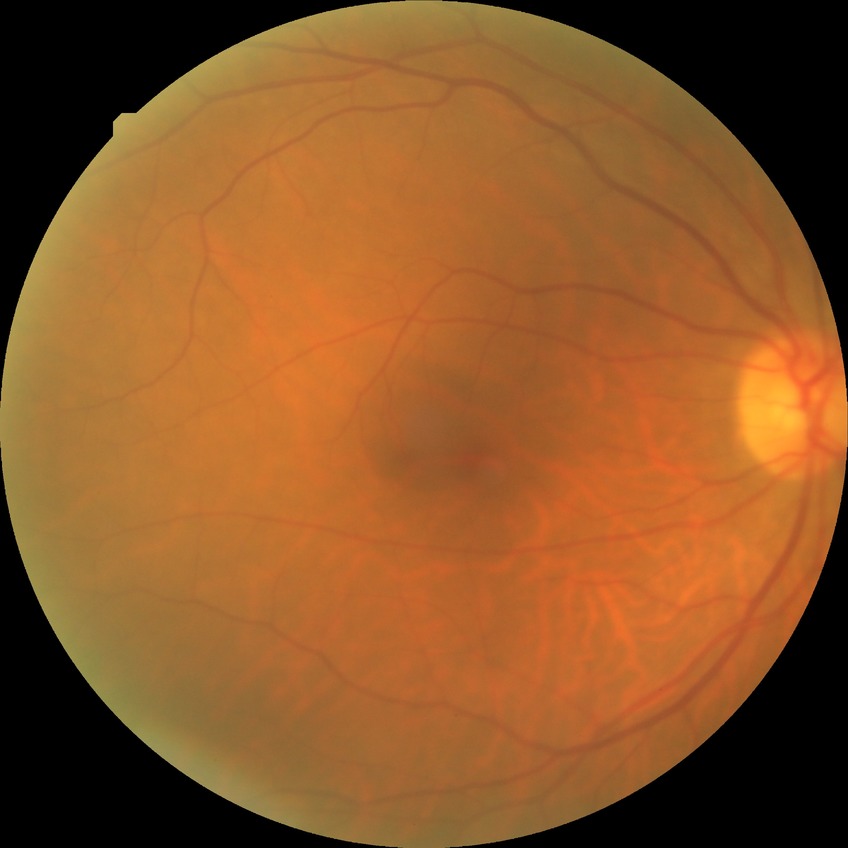 diabetic retinopathy (DR): NDR (no diabetic retinopathy)